Dilated-pupil acquisition.
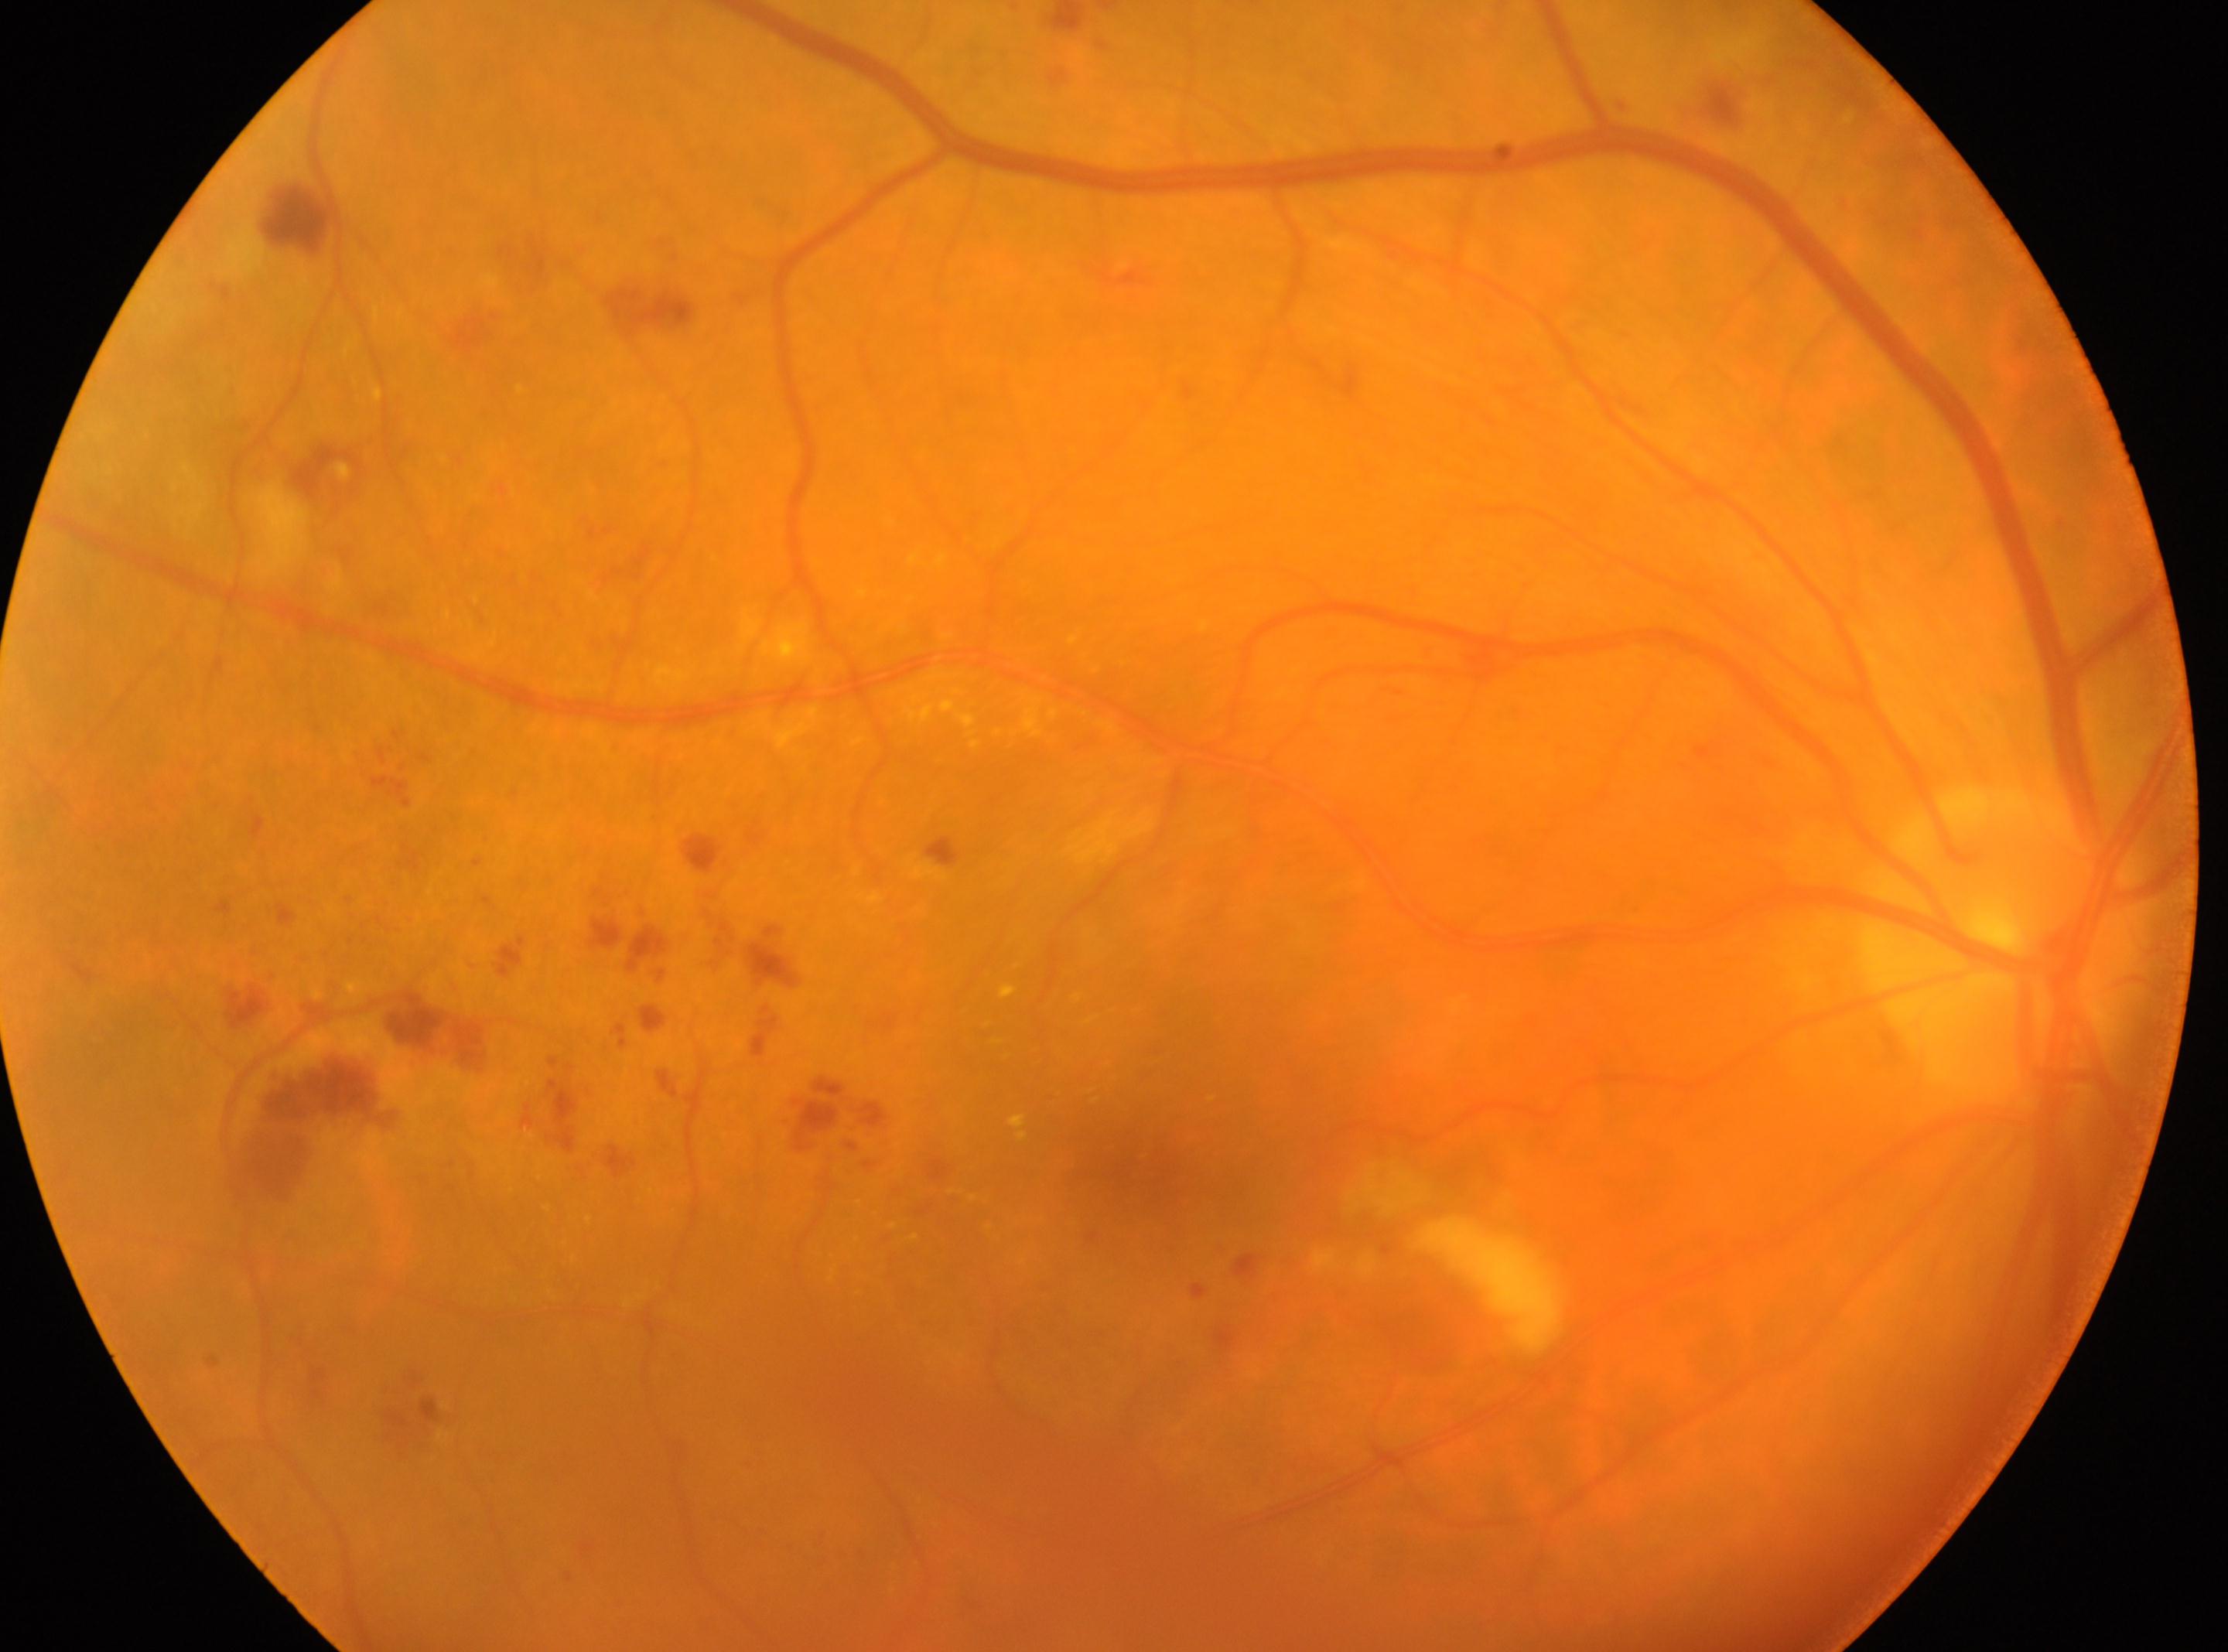
Q: DR stage?
A: 2
Q: Where is the optic disc?
A: (x=2004, y=940)
Q: Right or left eye?
A: the right eye
Q: Where is the fovea?
A: (x=1140, y=1166)